Graded on the modified Davis scale; fundus photo — 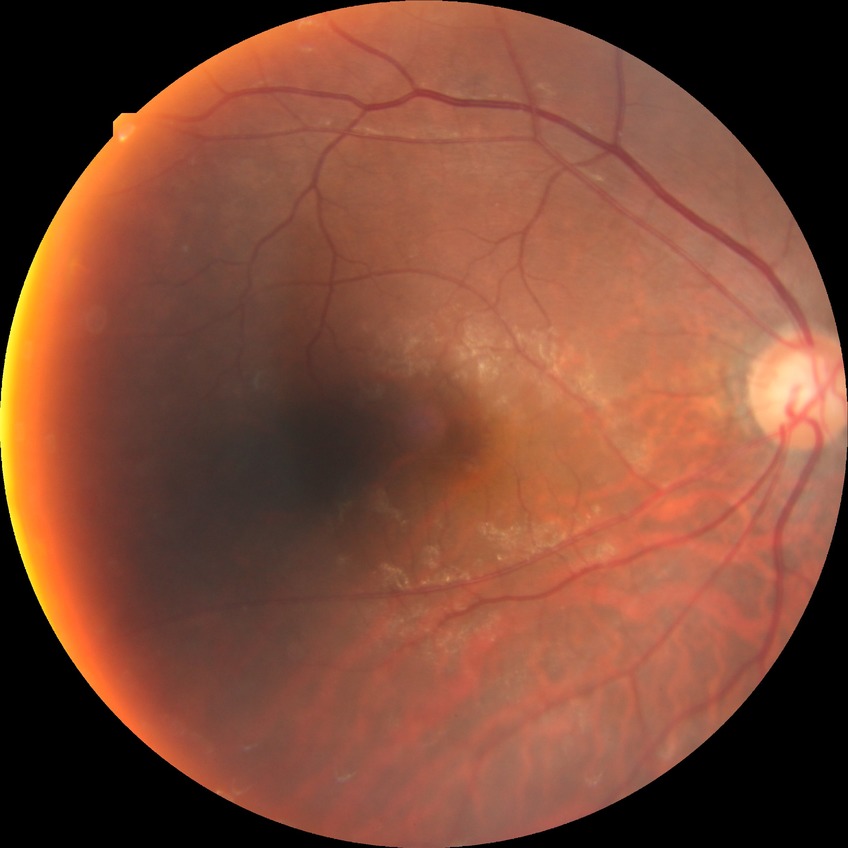 {"davis_grade": "SDR (simple diabetic retinopathy)", "proliferative_class": "non-proliferative diabetic retinopathy"}